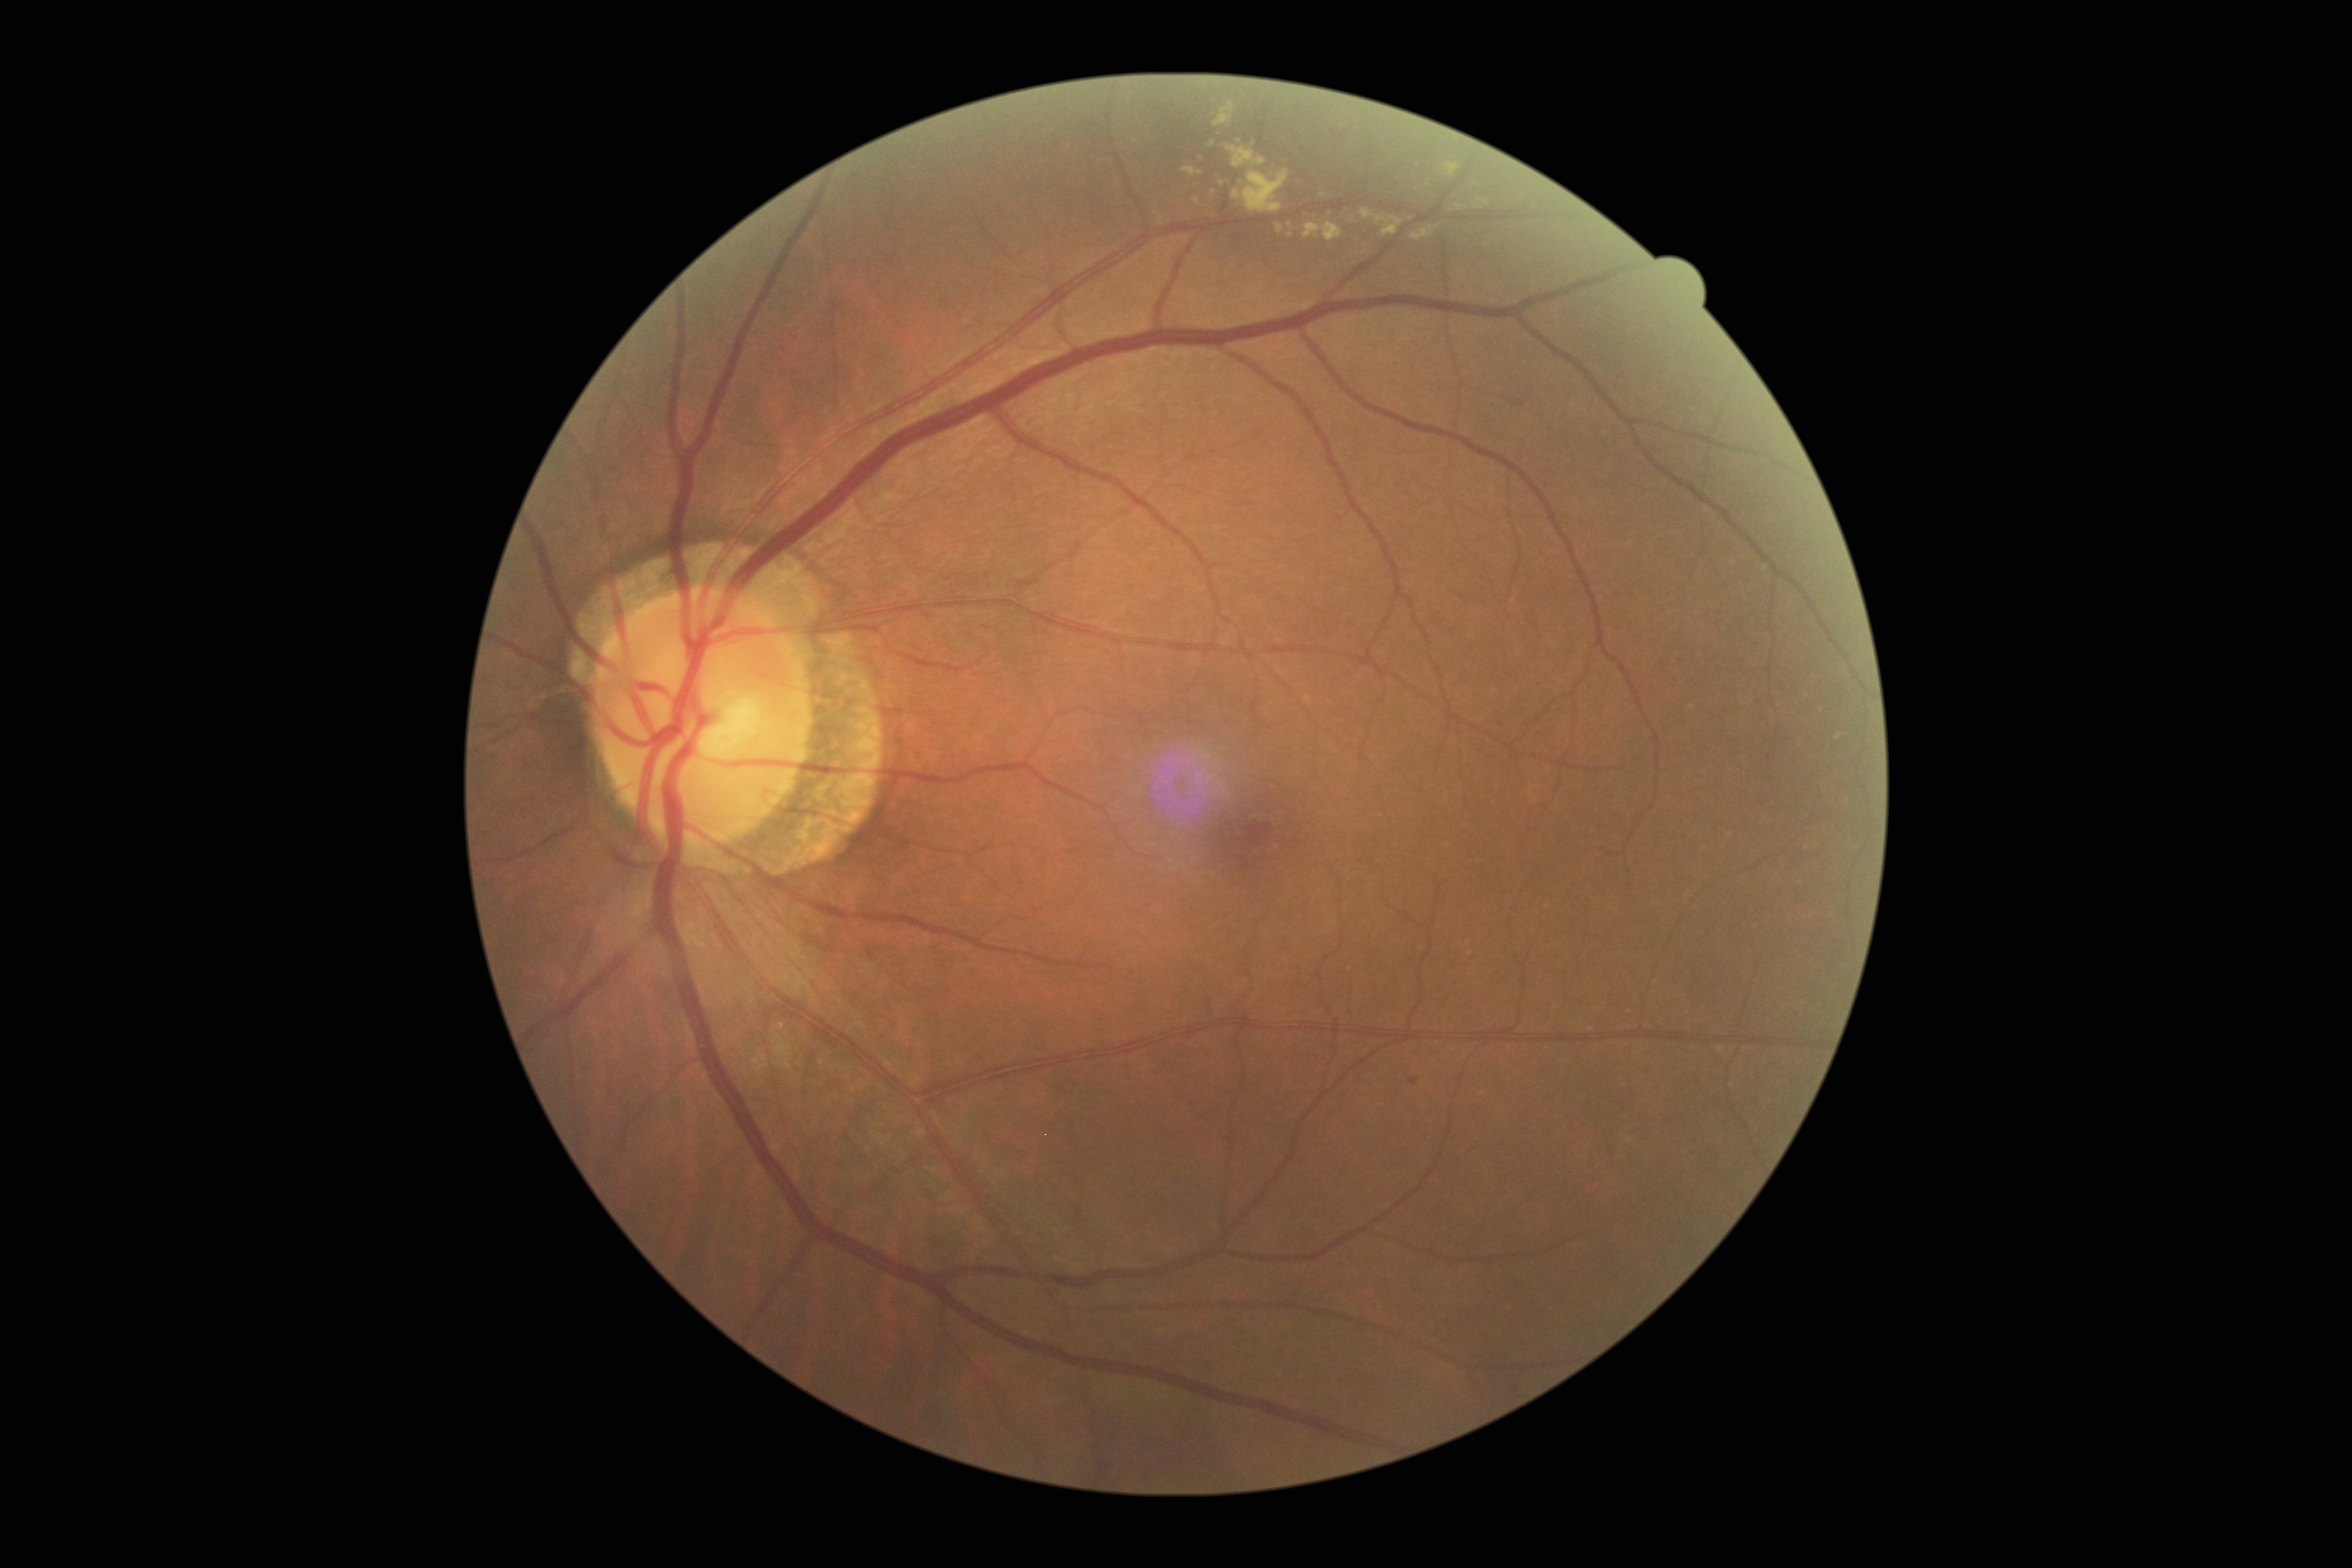
DR grade: moderate NPDR (2).